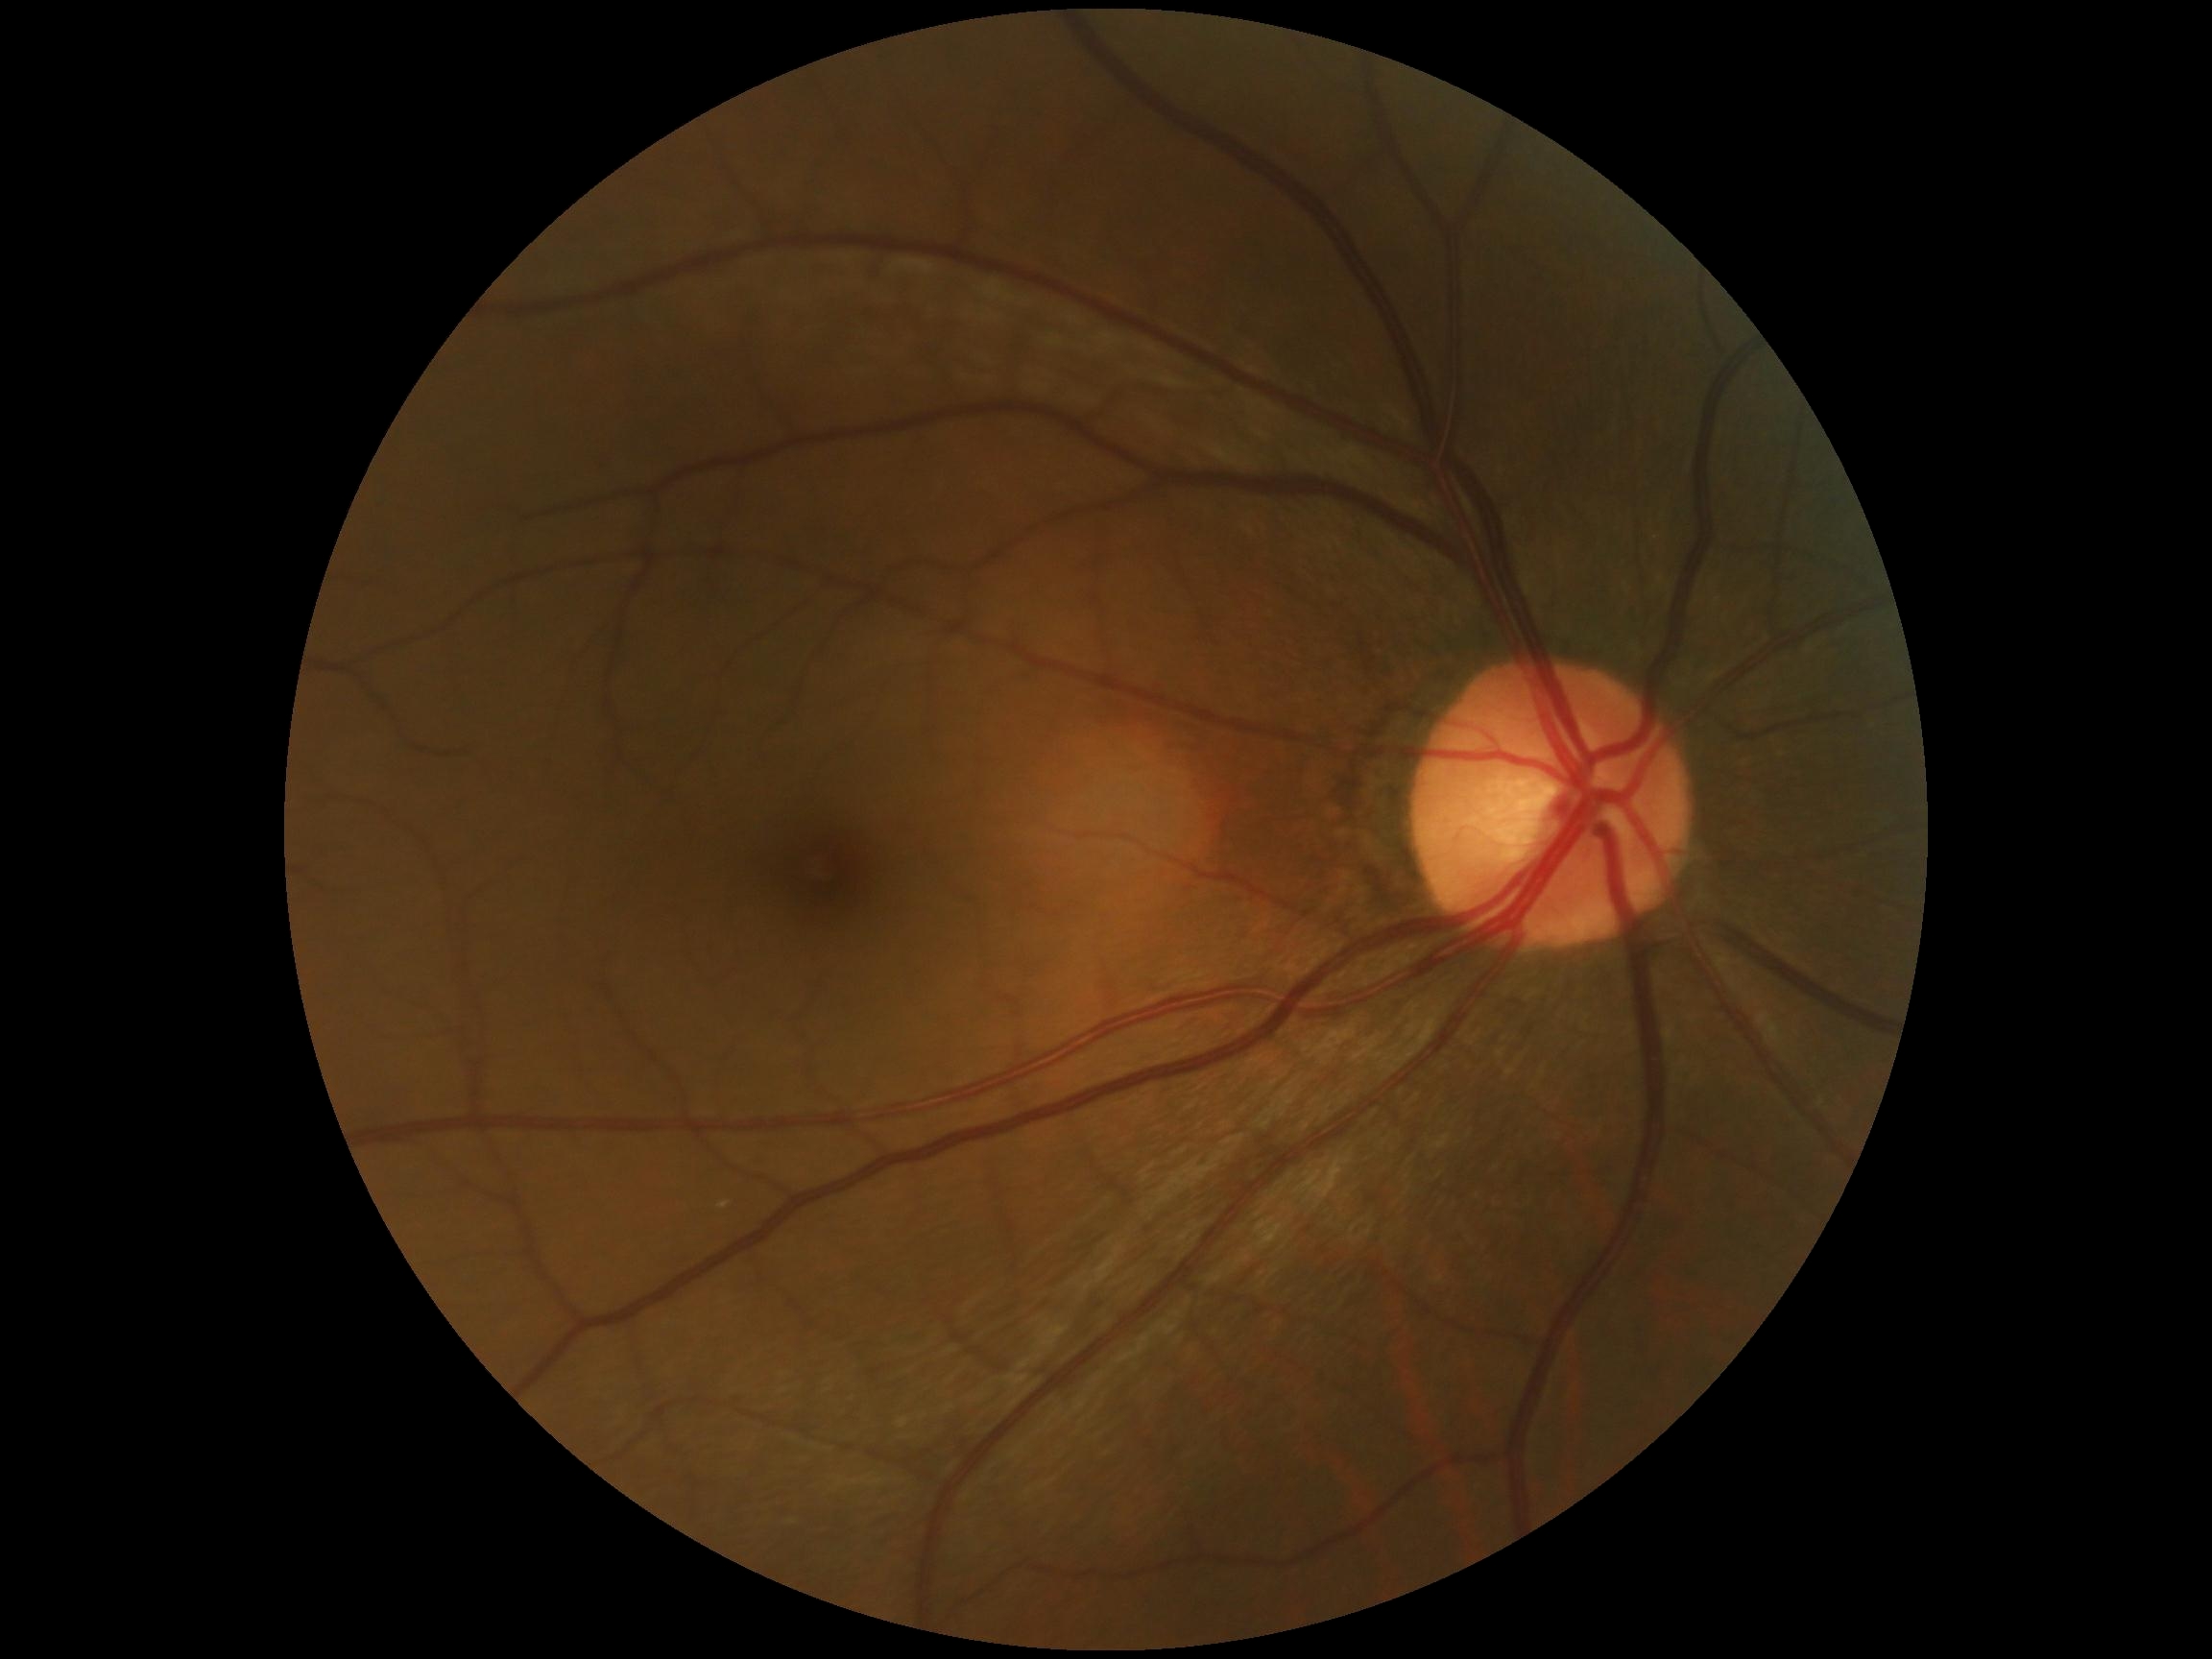 DR stage is grade 0 (no apparent retinopathy).